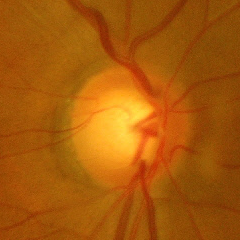 Optic disc appearance consistent with advanced glaucomatous optic neuropathy.